Wide-field contact fundus photograph of an infant; image size 1440x1080: 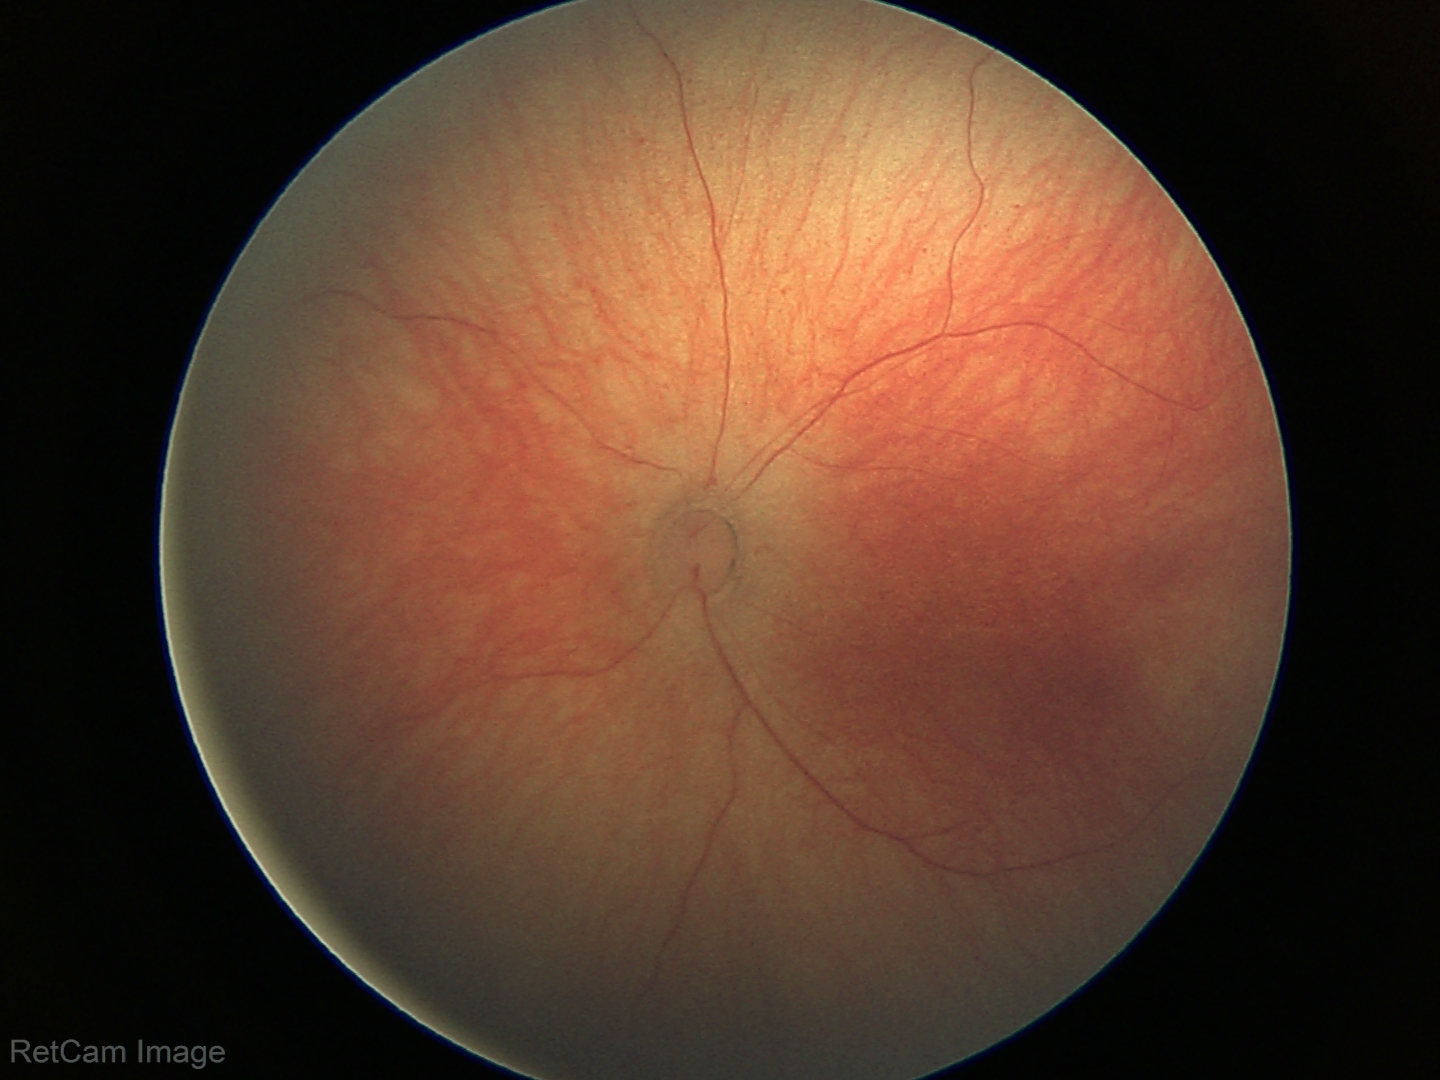 Finding = normal retinal appearance